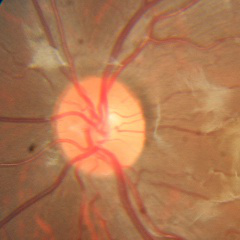
Optic disc appearance consistent with no evidence of glaucoma.